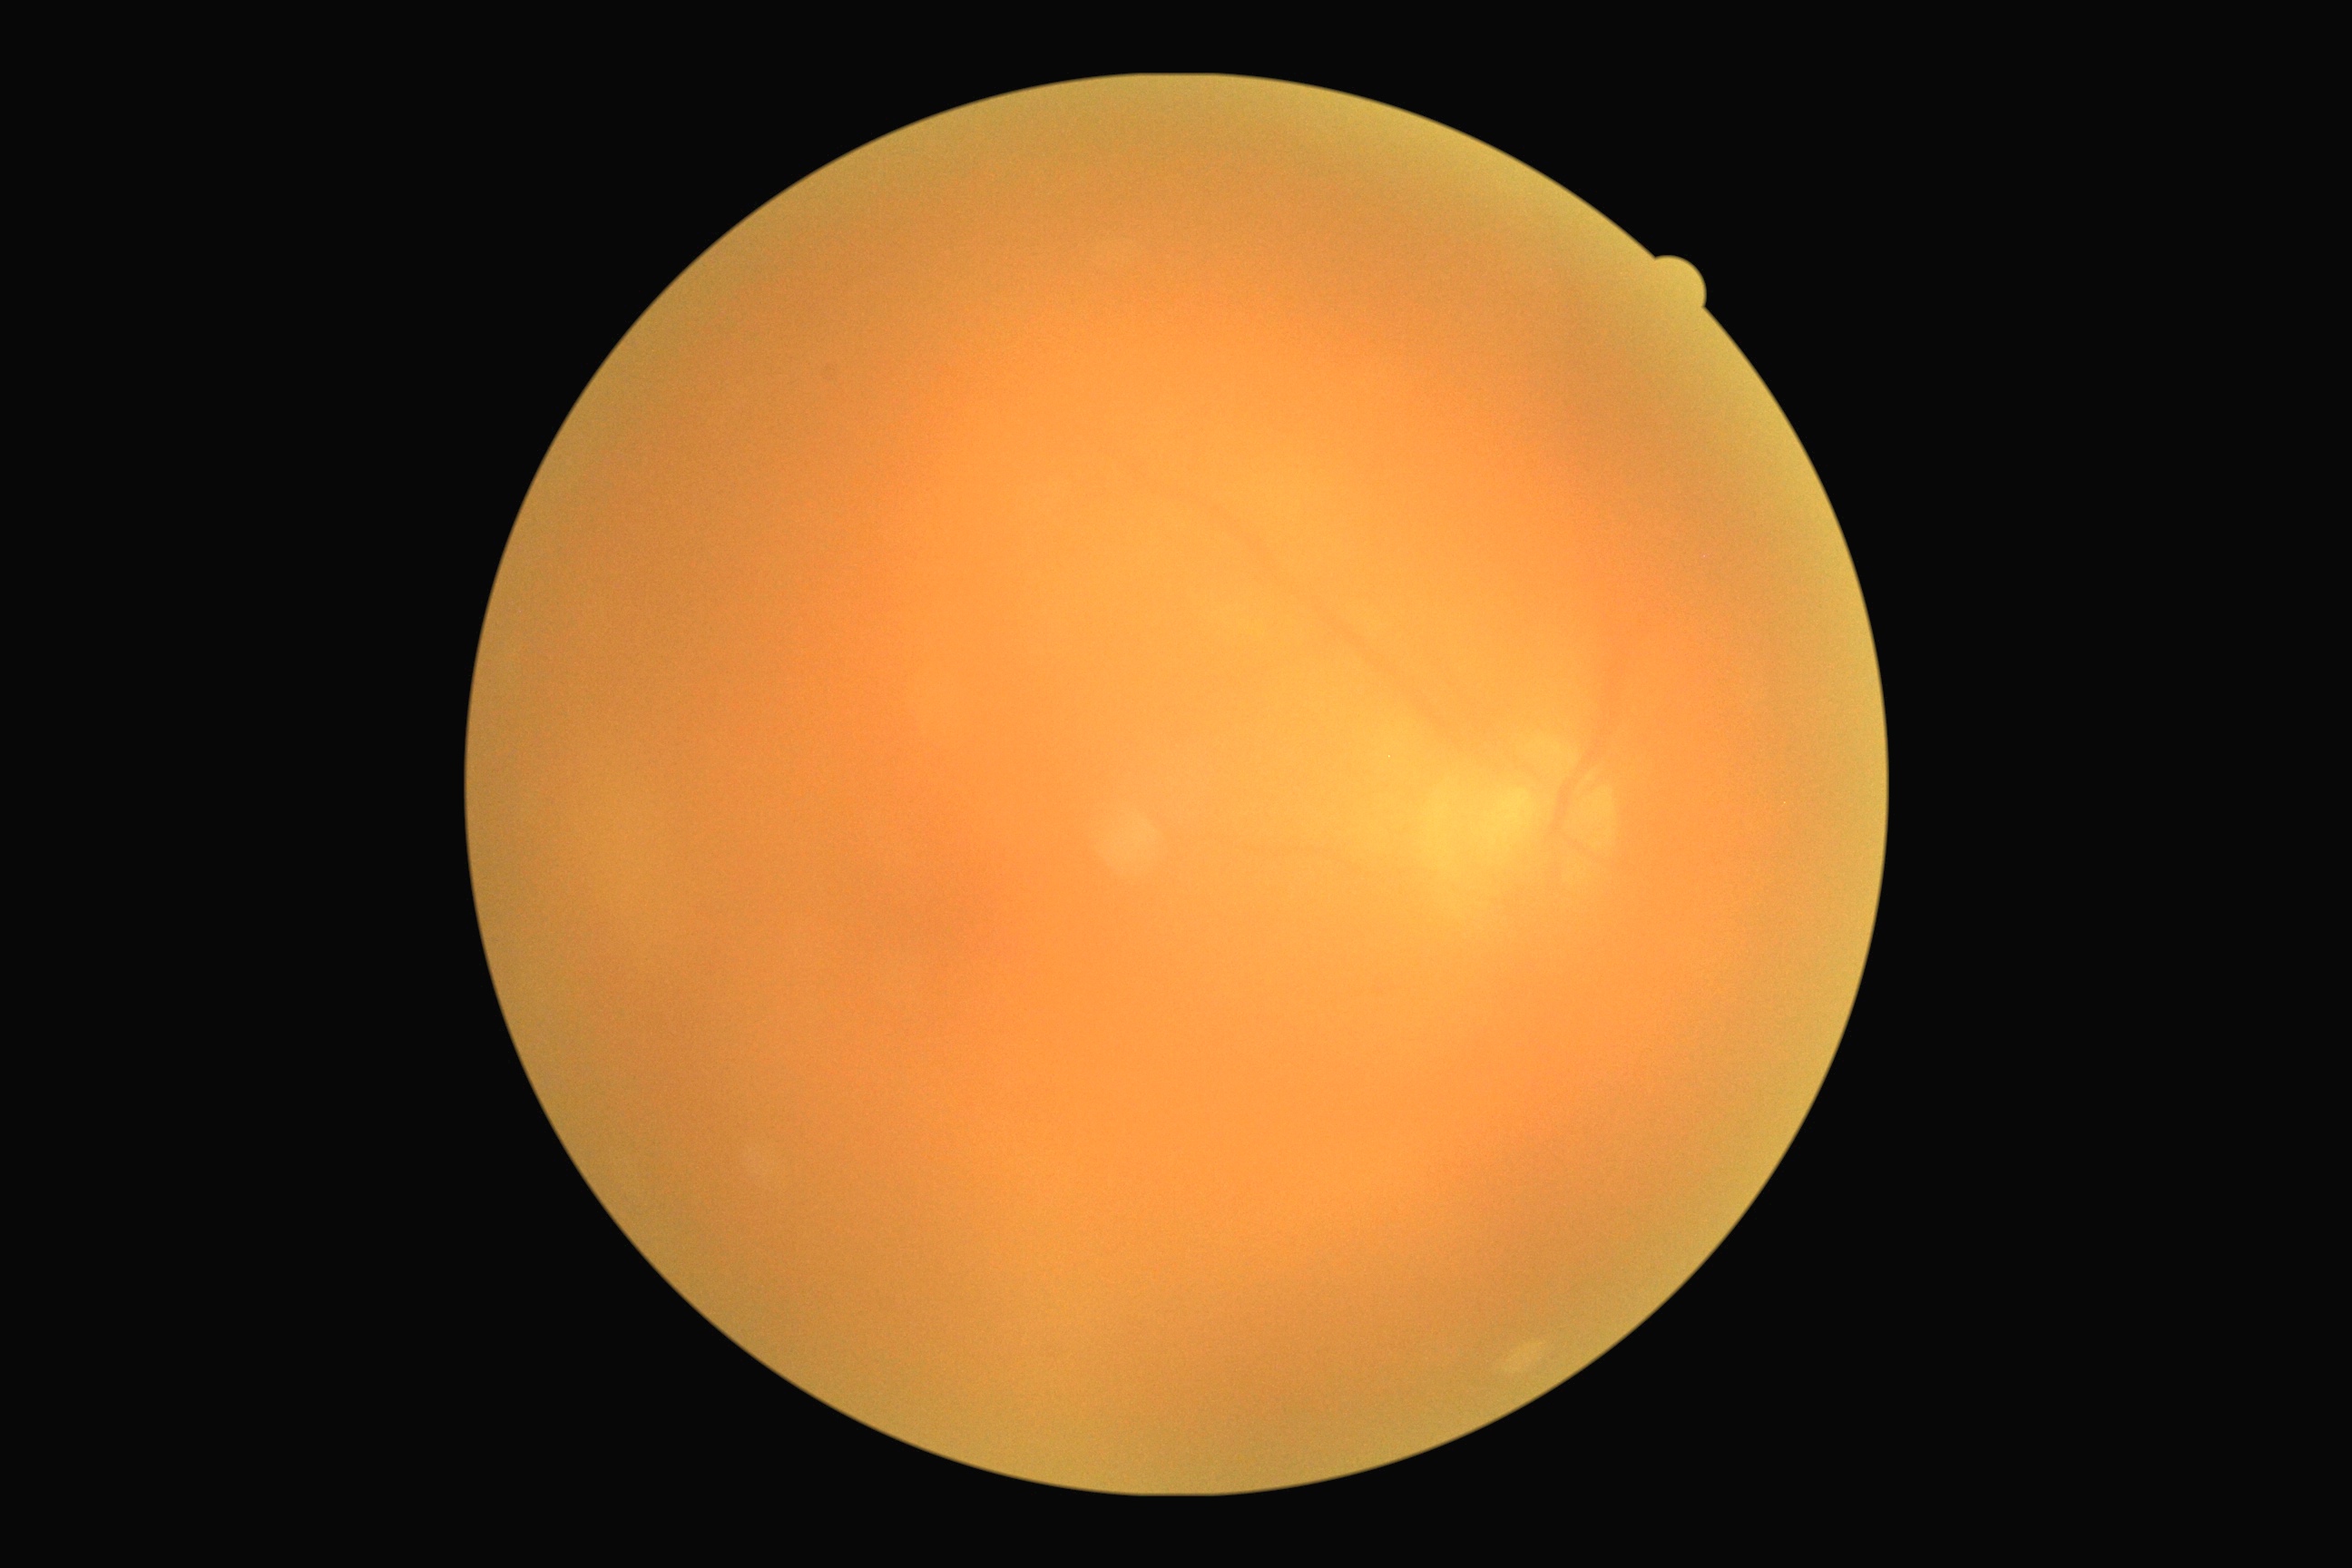

DR grade is ungradable due to poor image quality.